NIDEK AFC-230 fundus camera. FOV: 45 degrees
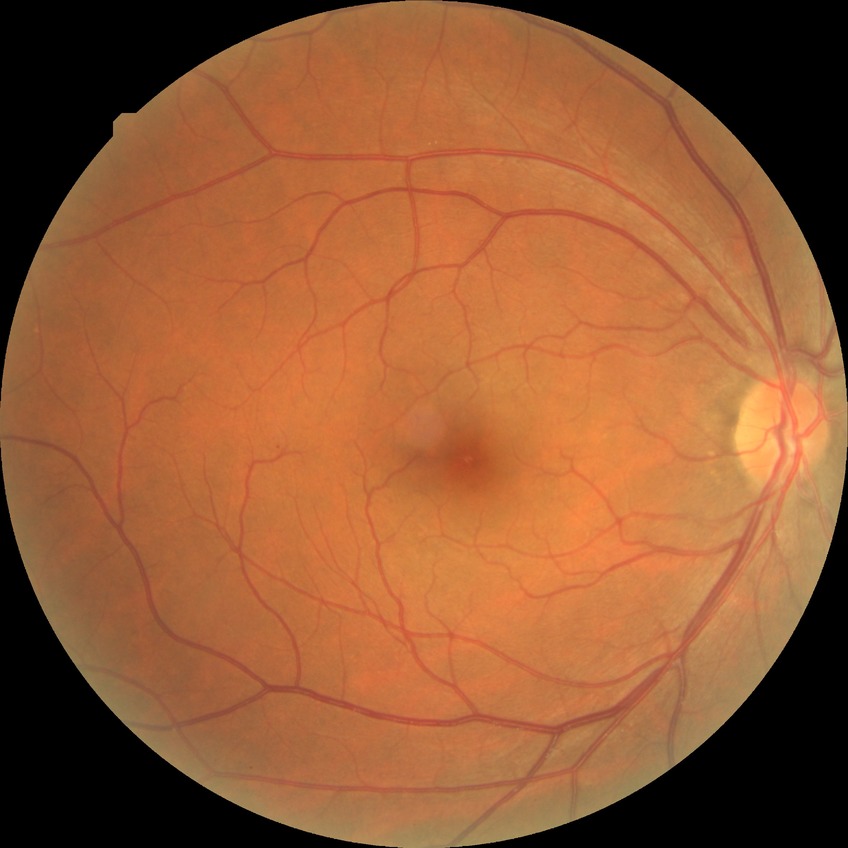
Diabetic retinopathy (DR) is SDR (simple diabetic retinopathy).